45° FOV; Davis DR grading.
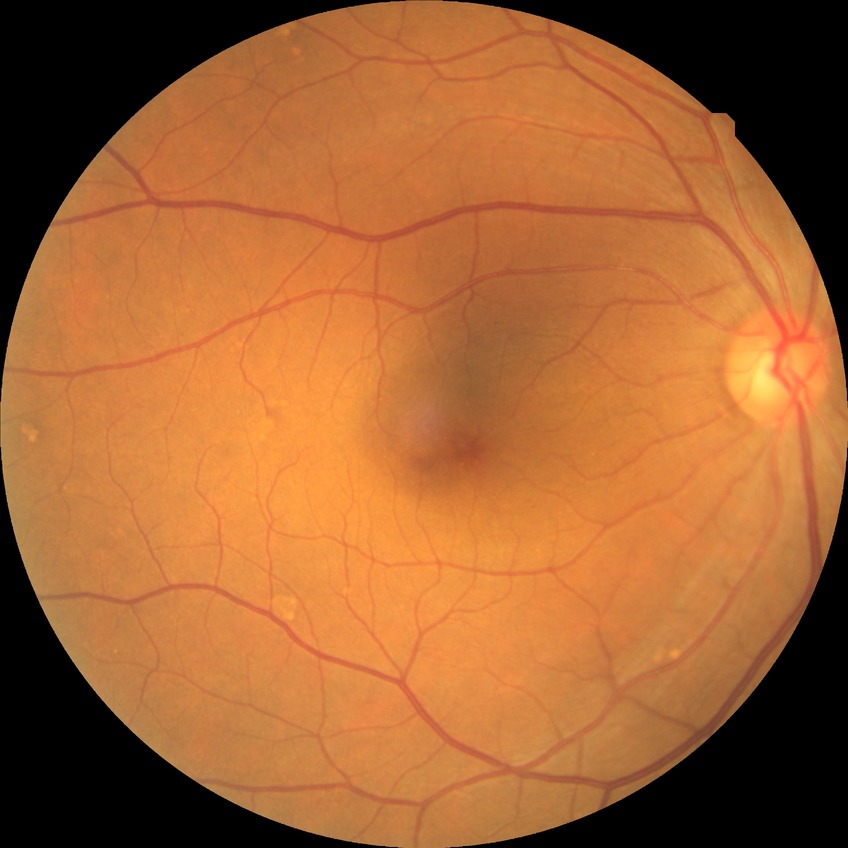 DR impression: no DR findings
modified Davis grade: NDR